Image size 2212x1659.
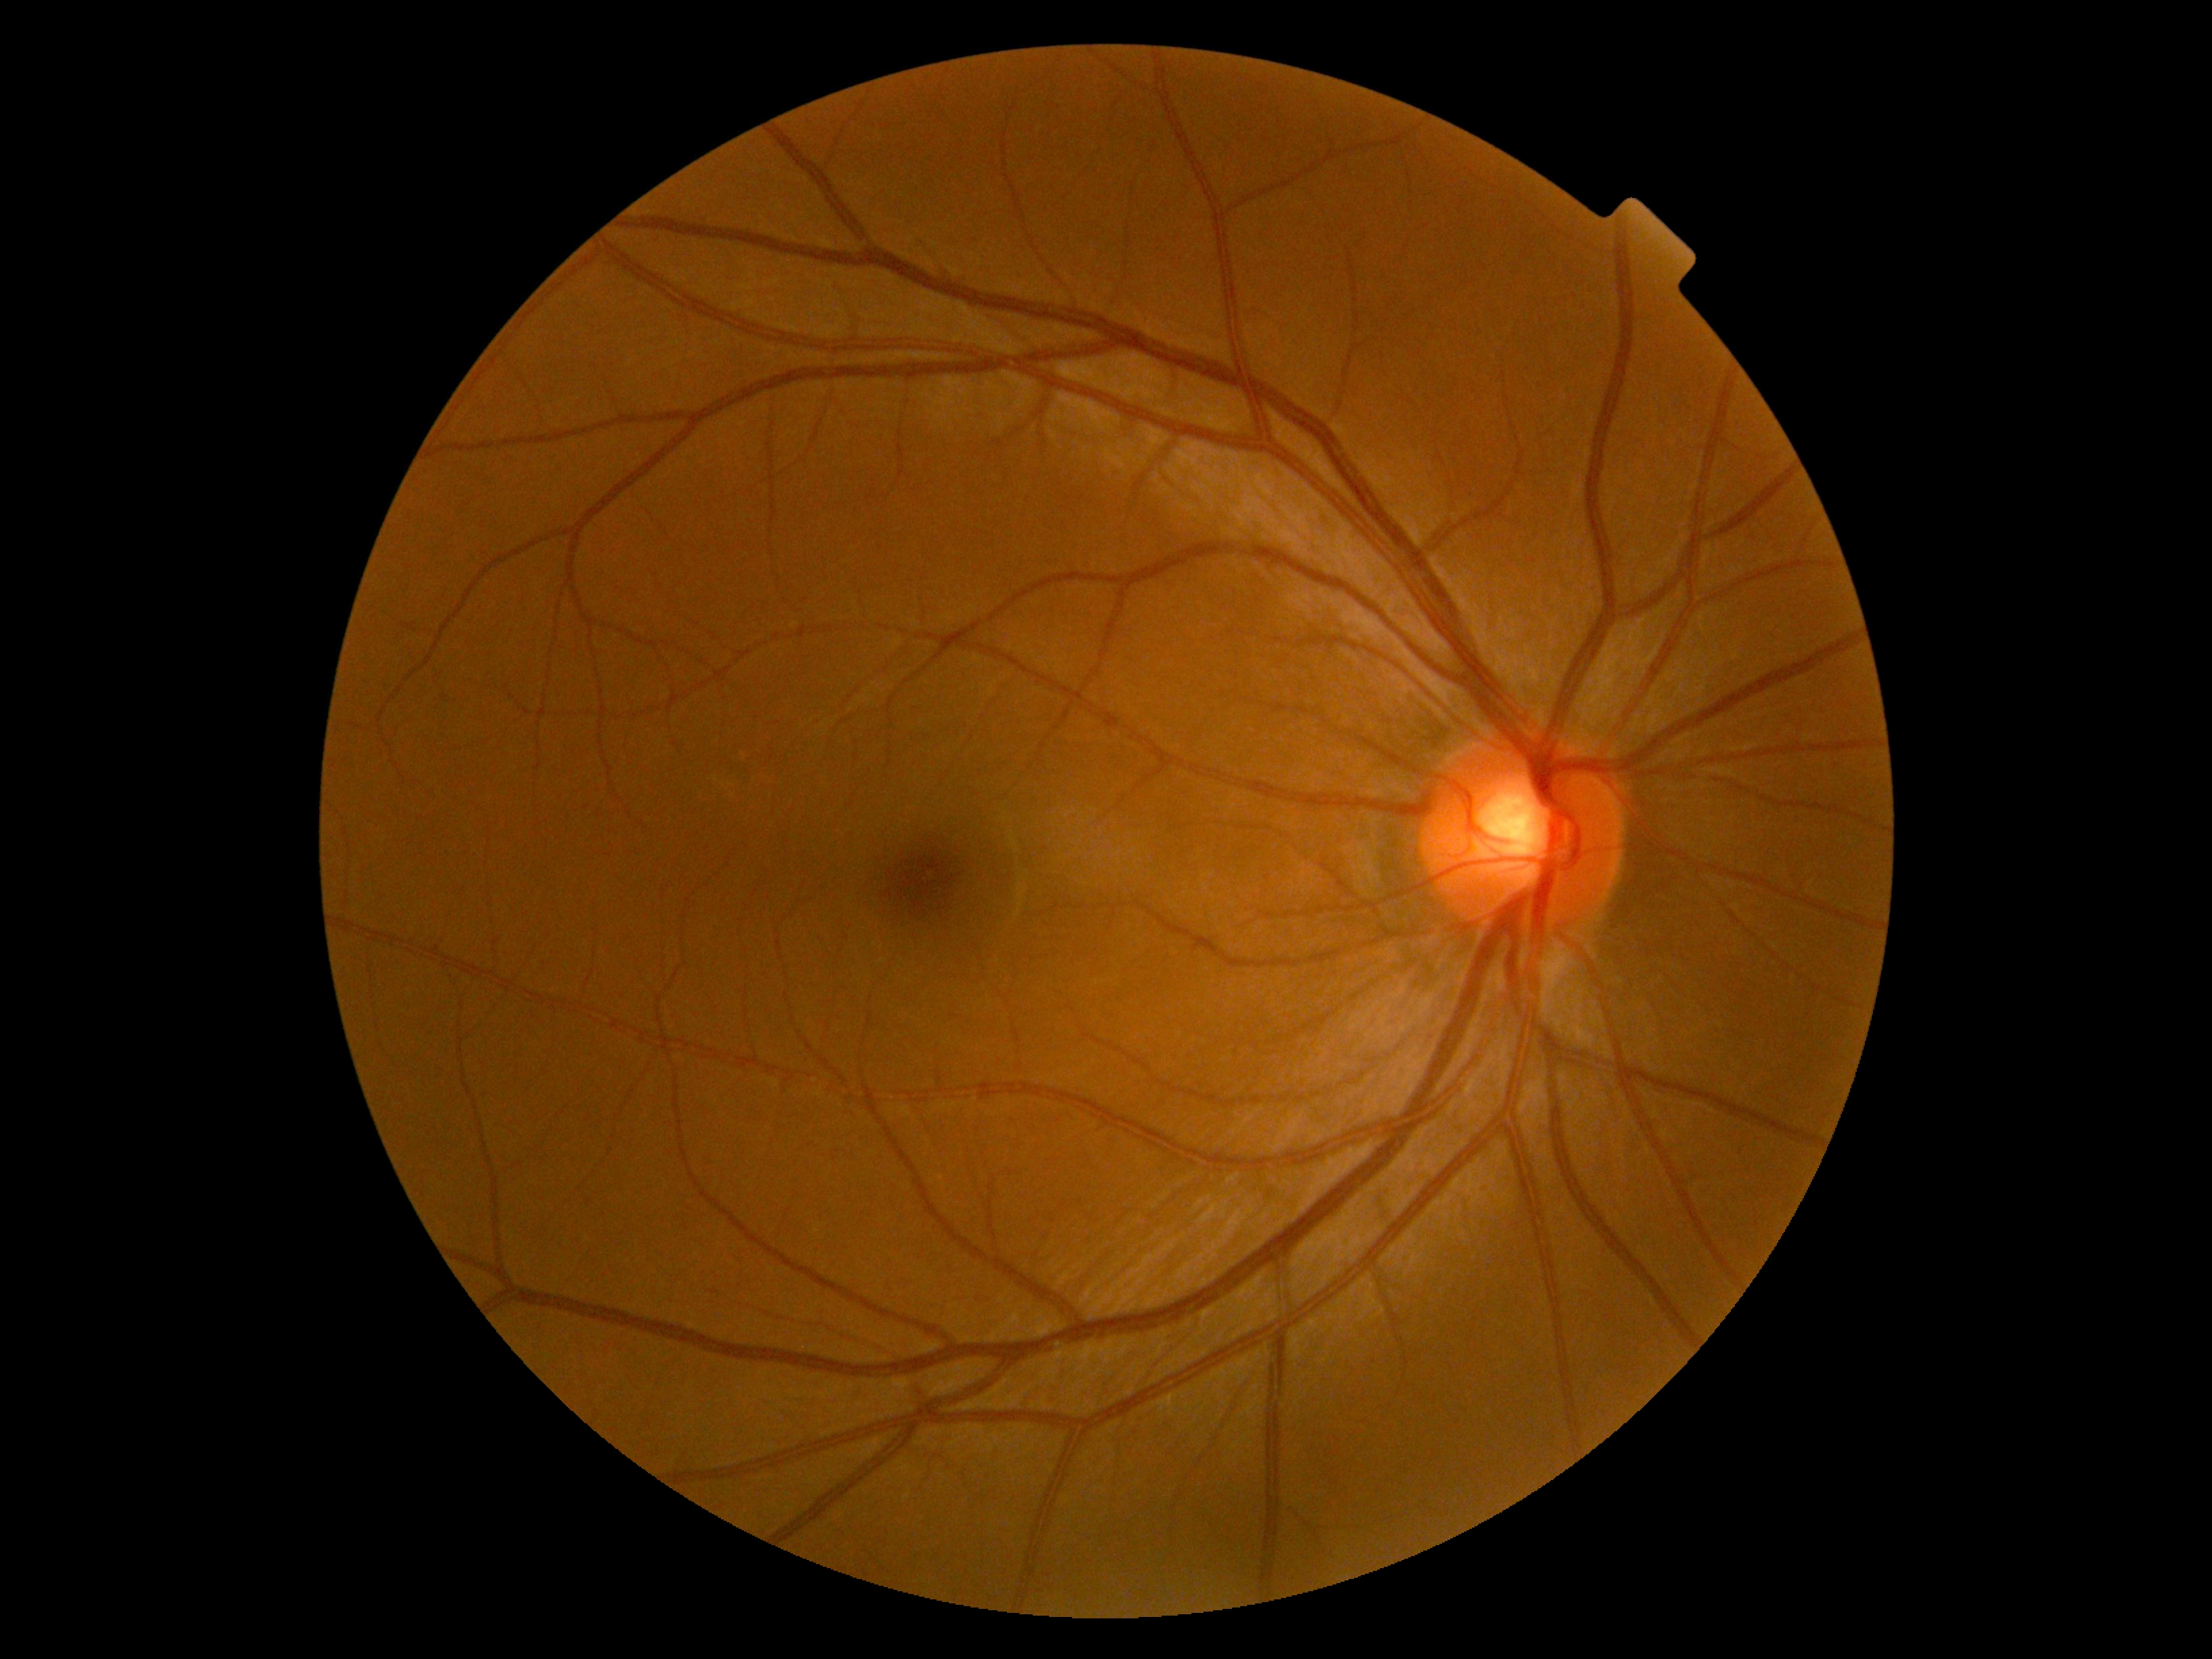

DR grade is 0.